848 x 848 pixels.
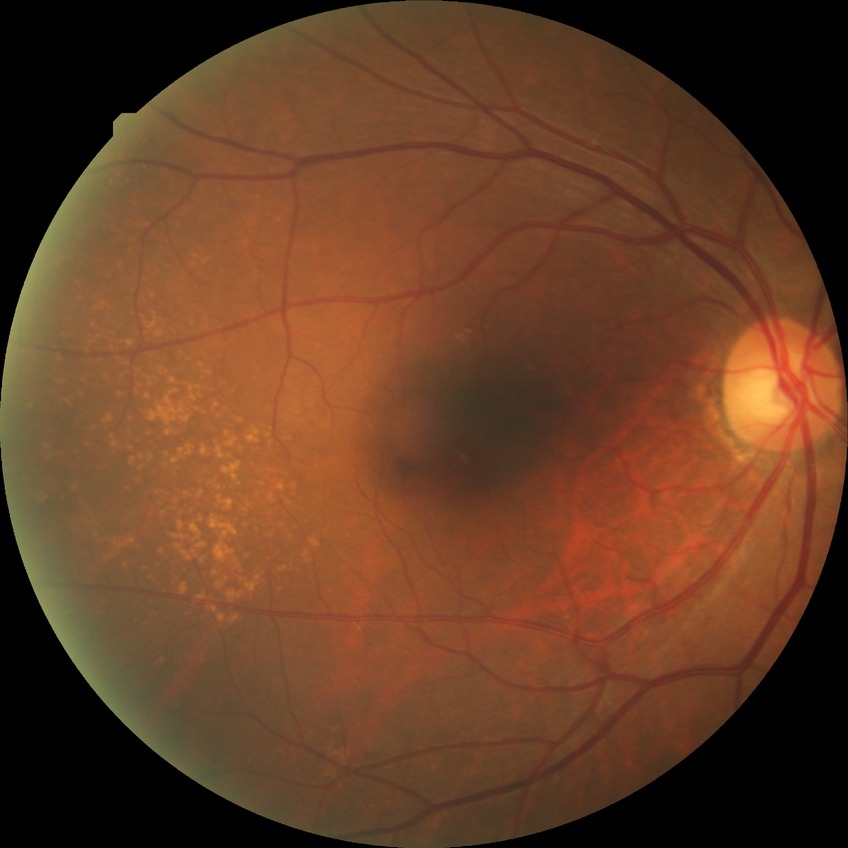
Diabetic retinopathy stage: no diabetic retinopathy.